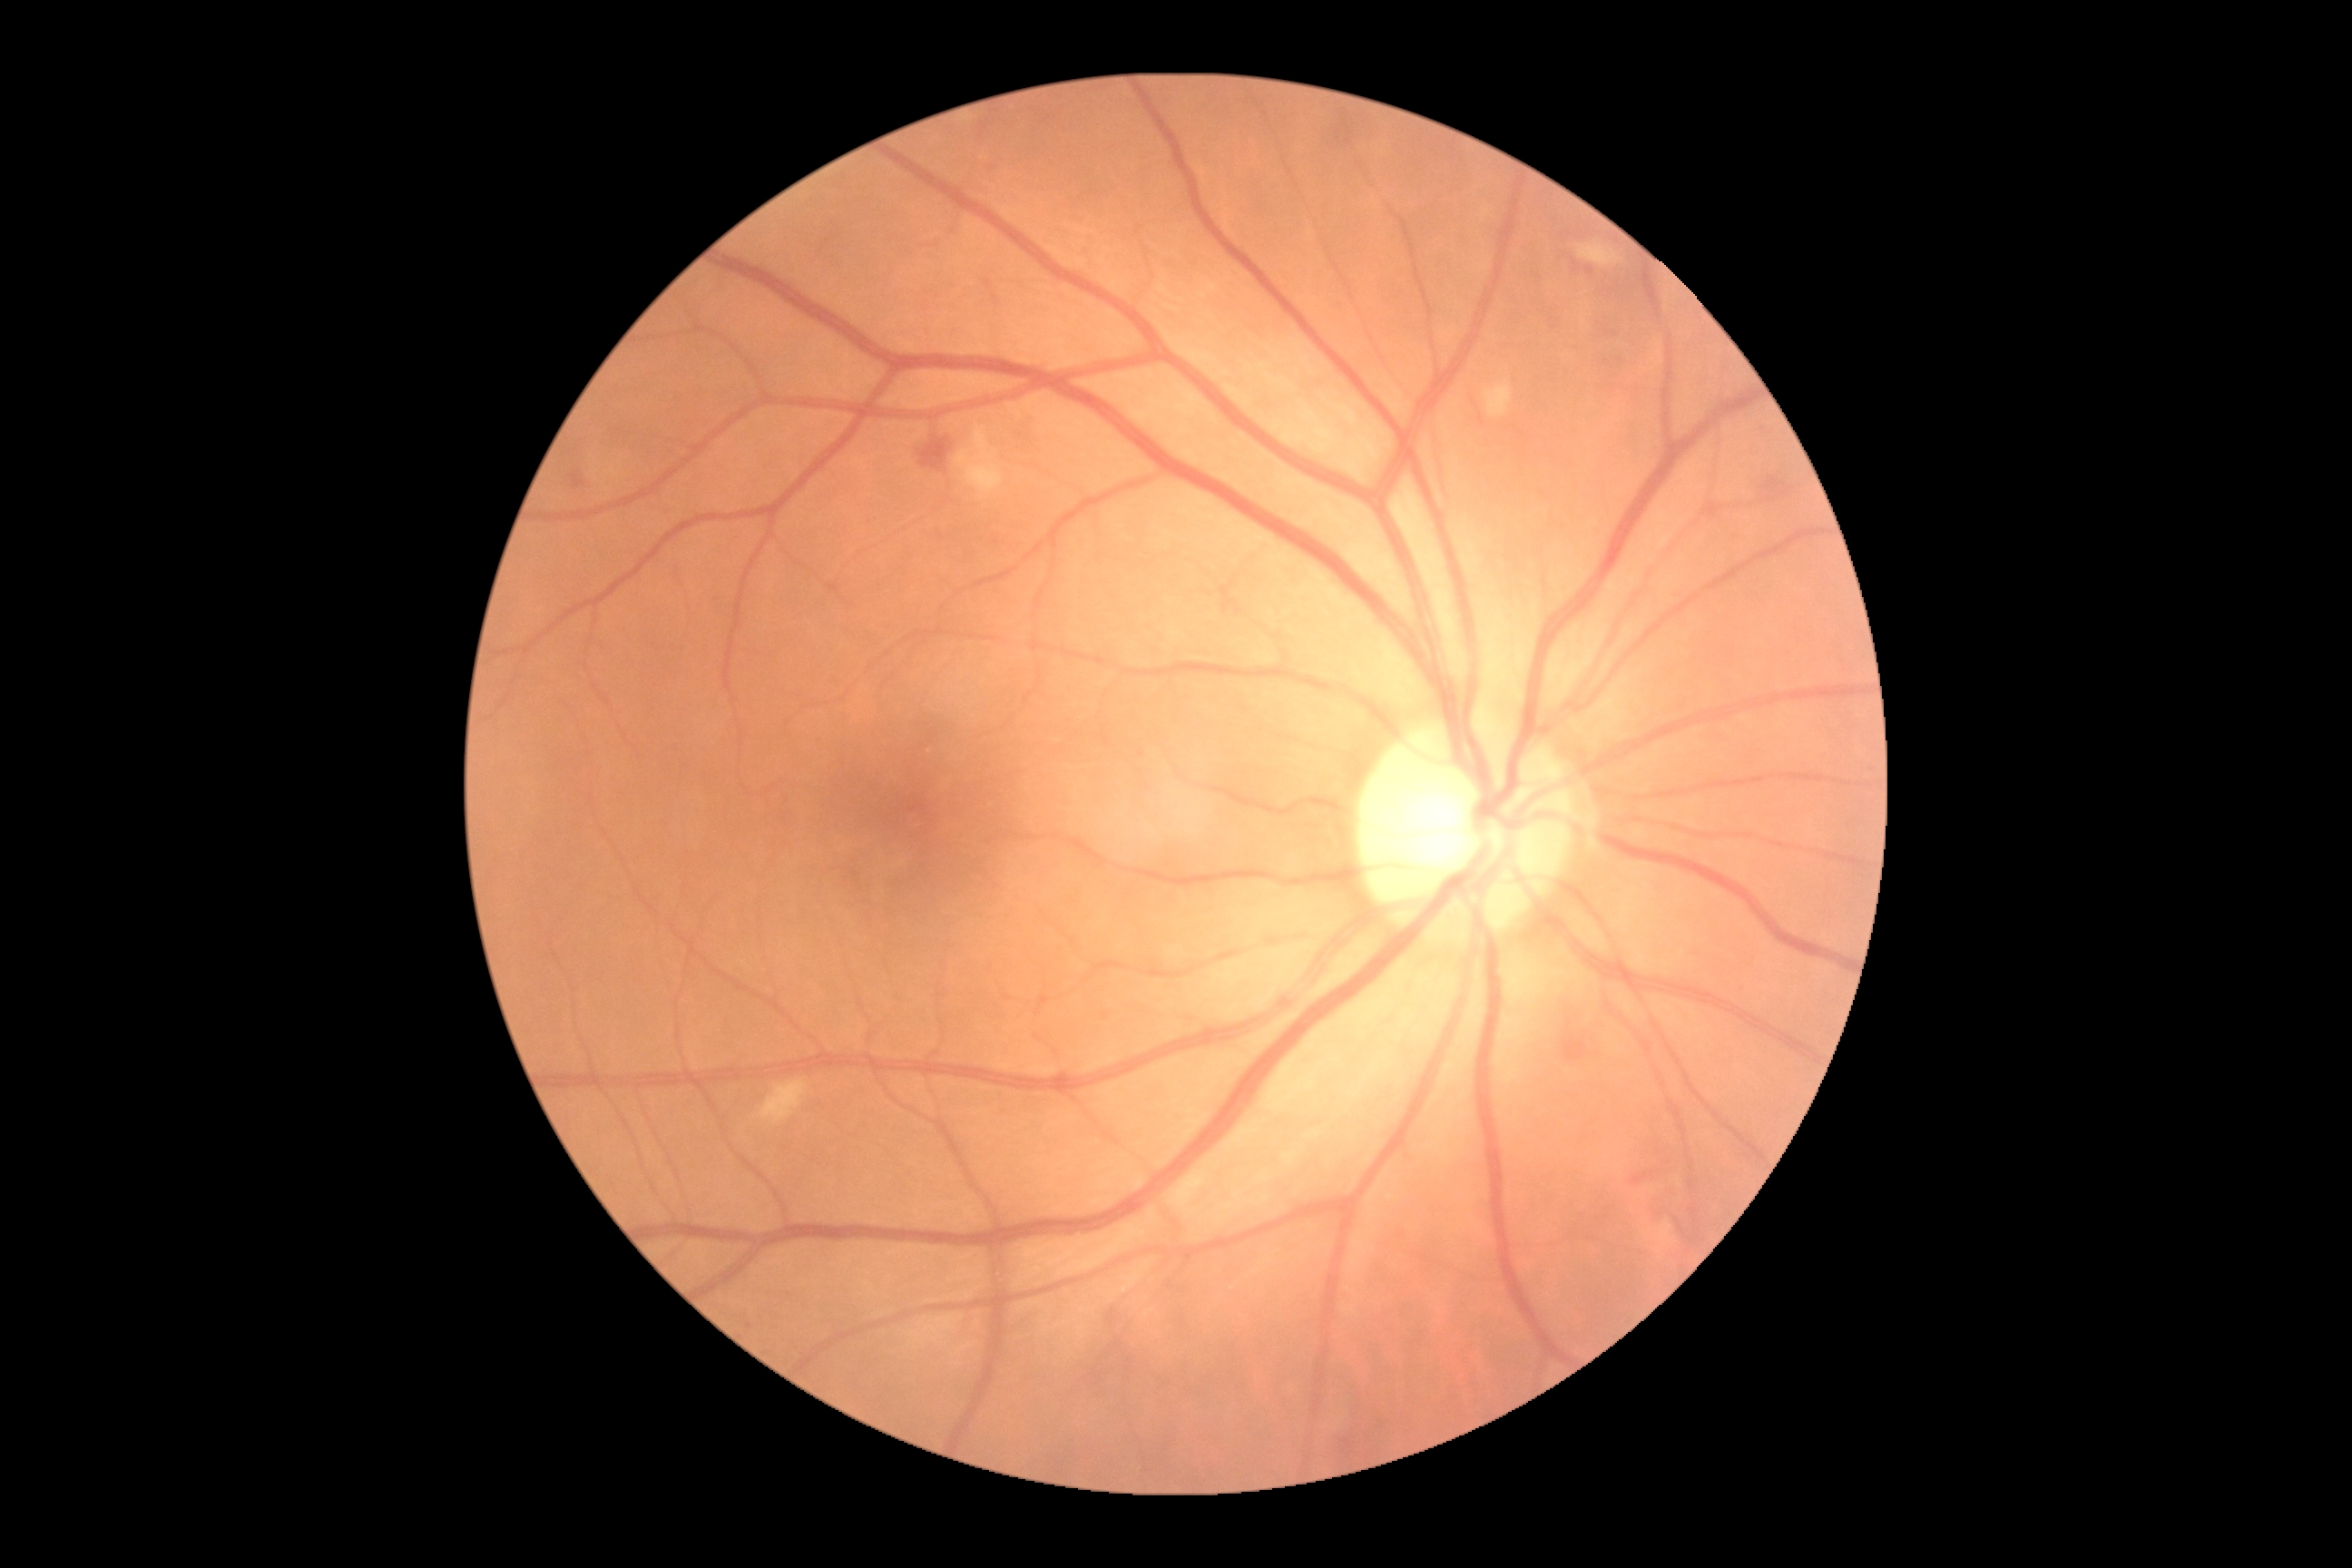 DR severity is 2/4 — more than just microaneurysms but less than severe NPDR.